Wide-field fundus photograph from neonatal ROP screening. Acquired on the Clarity RetCam 3
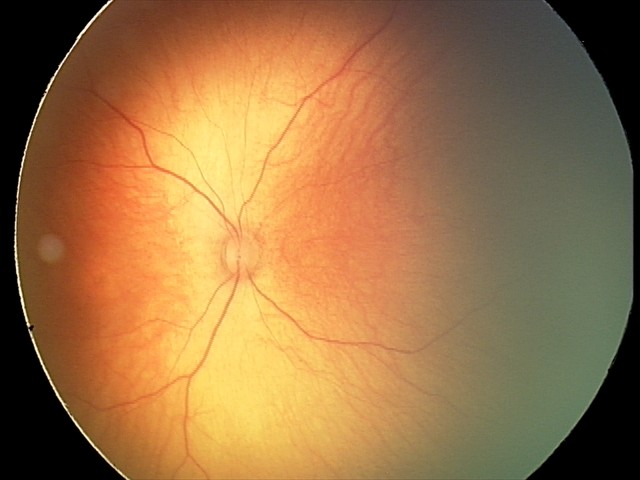
Finding = no pathology identified.